NIDEK AFC-230 fundus camera · 45° FOV · nonmydriatic fundus photograph · fundus photo · 848x848
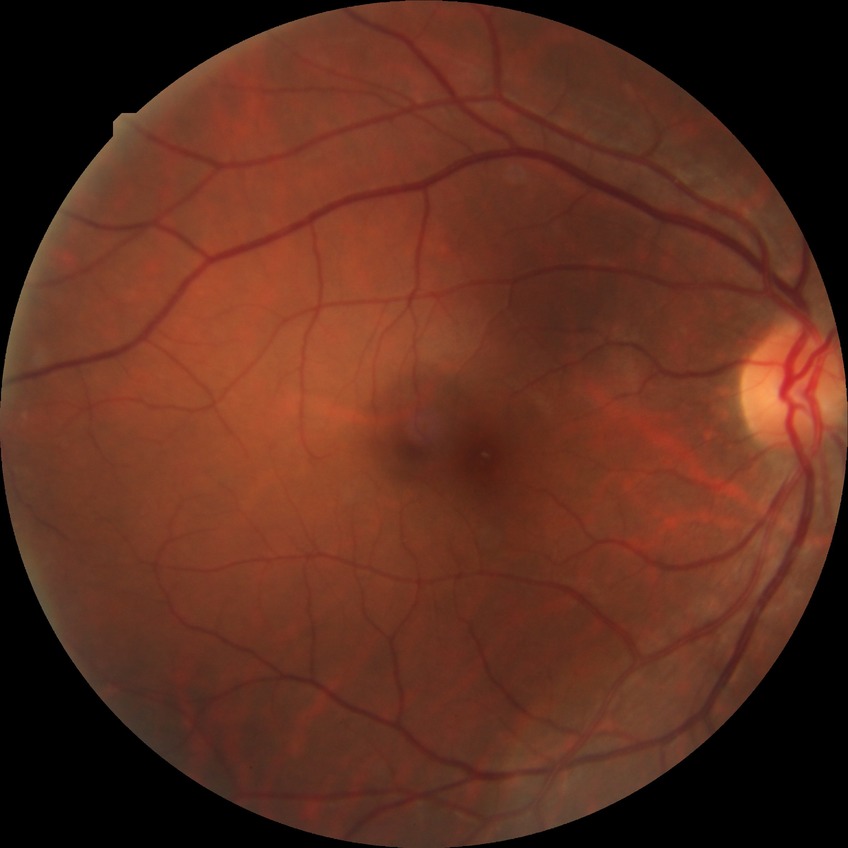 diabetic retinopathy severity: no diabetic retinopathy.